Clarity RetCam 3, 130° FOV; pediatric retinal photograph (wide-field); 640 x 480 pixels: 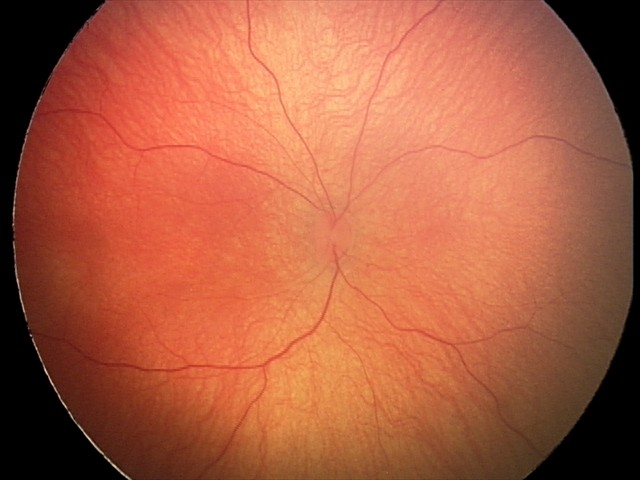

Normal screening examination.